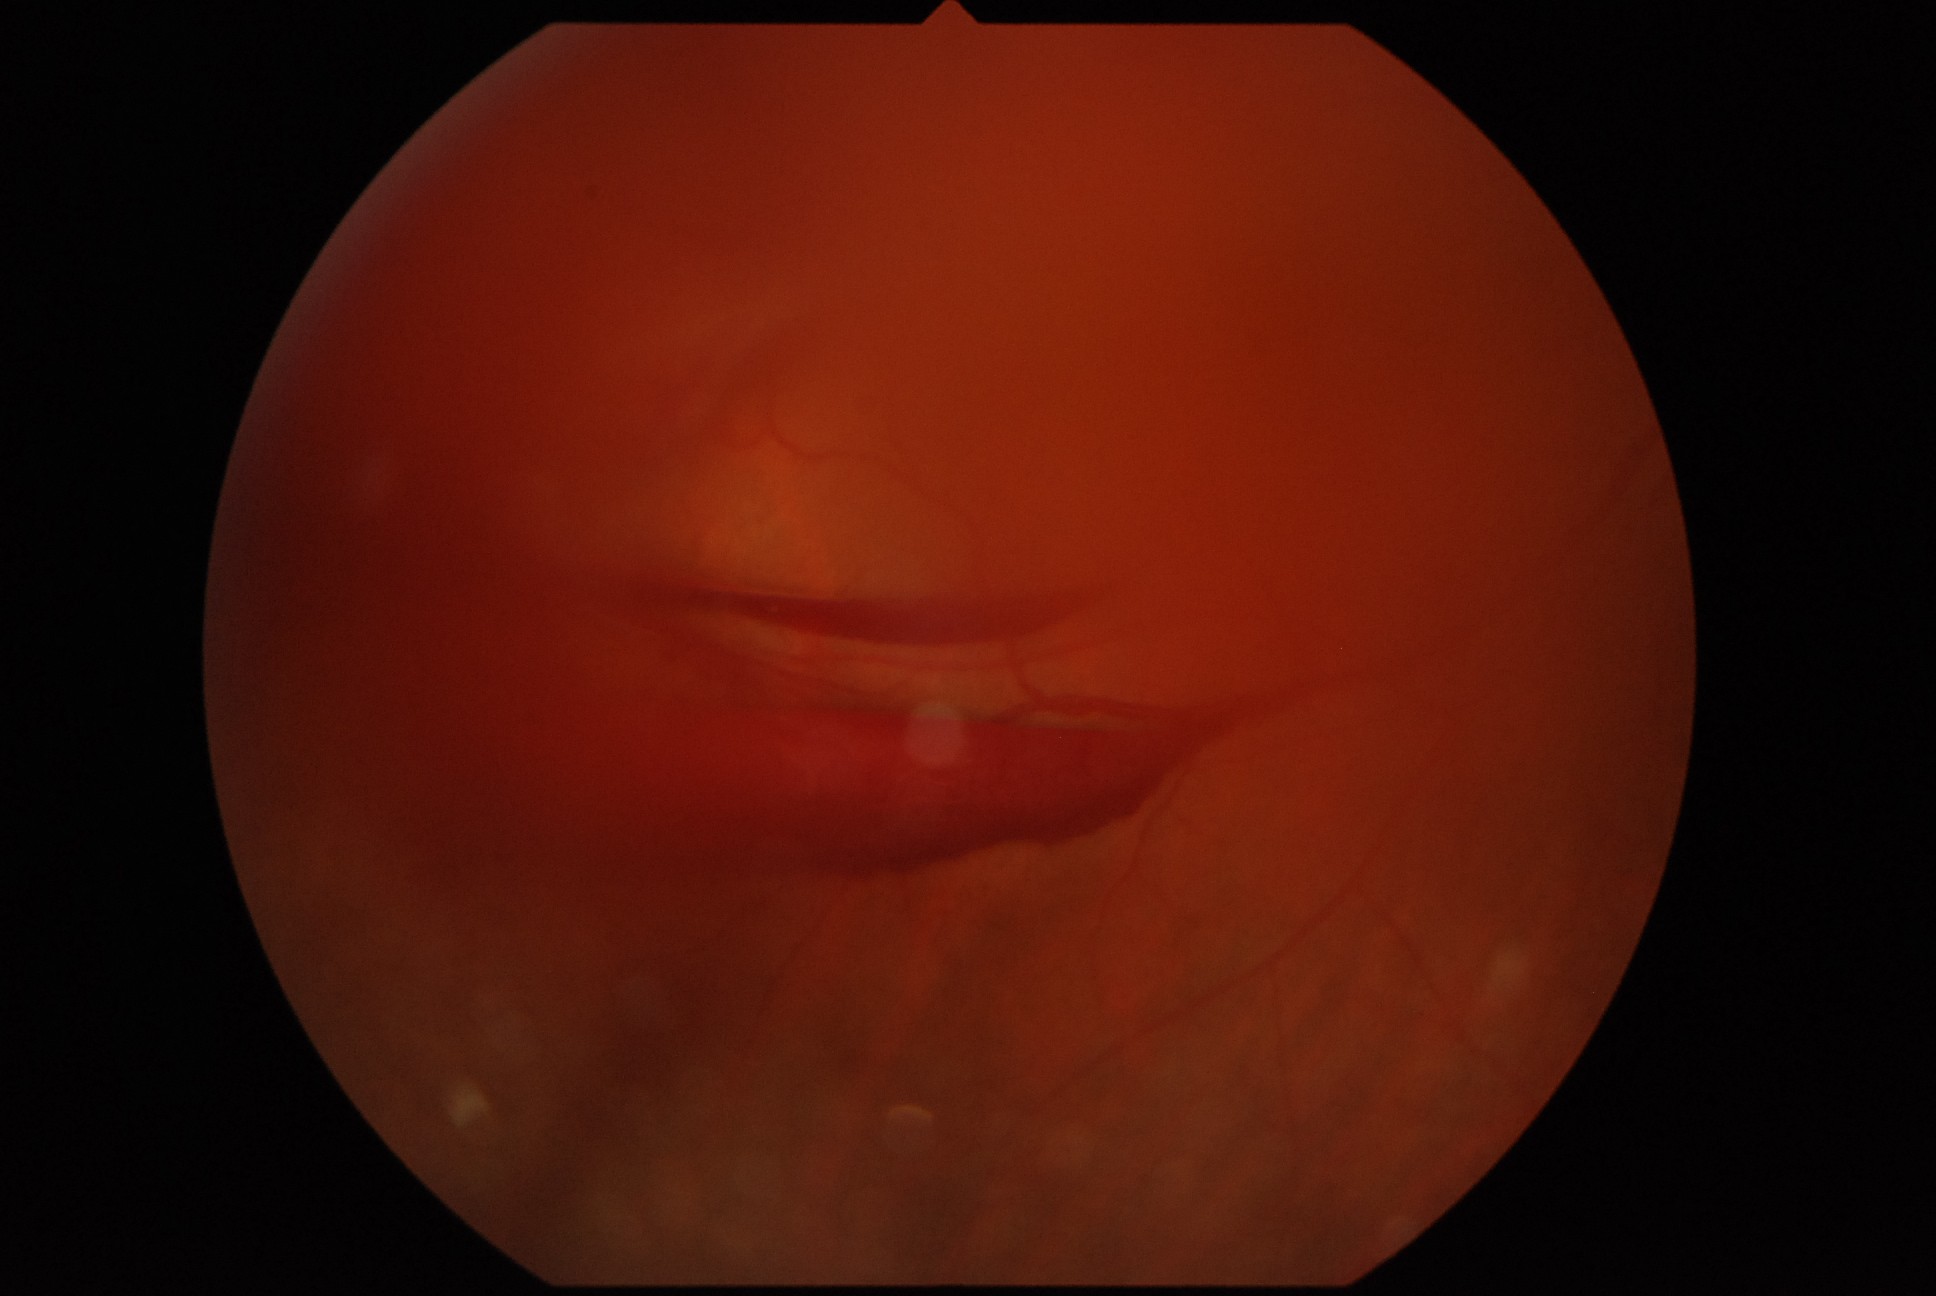 Disease class: proliferative diabetic retinopathy. DR stage is 4.